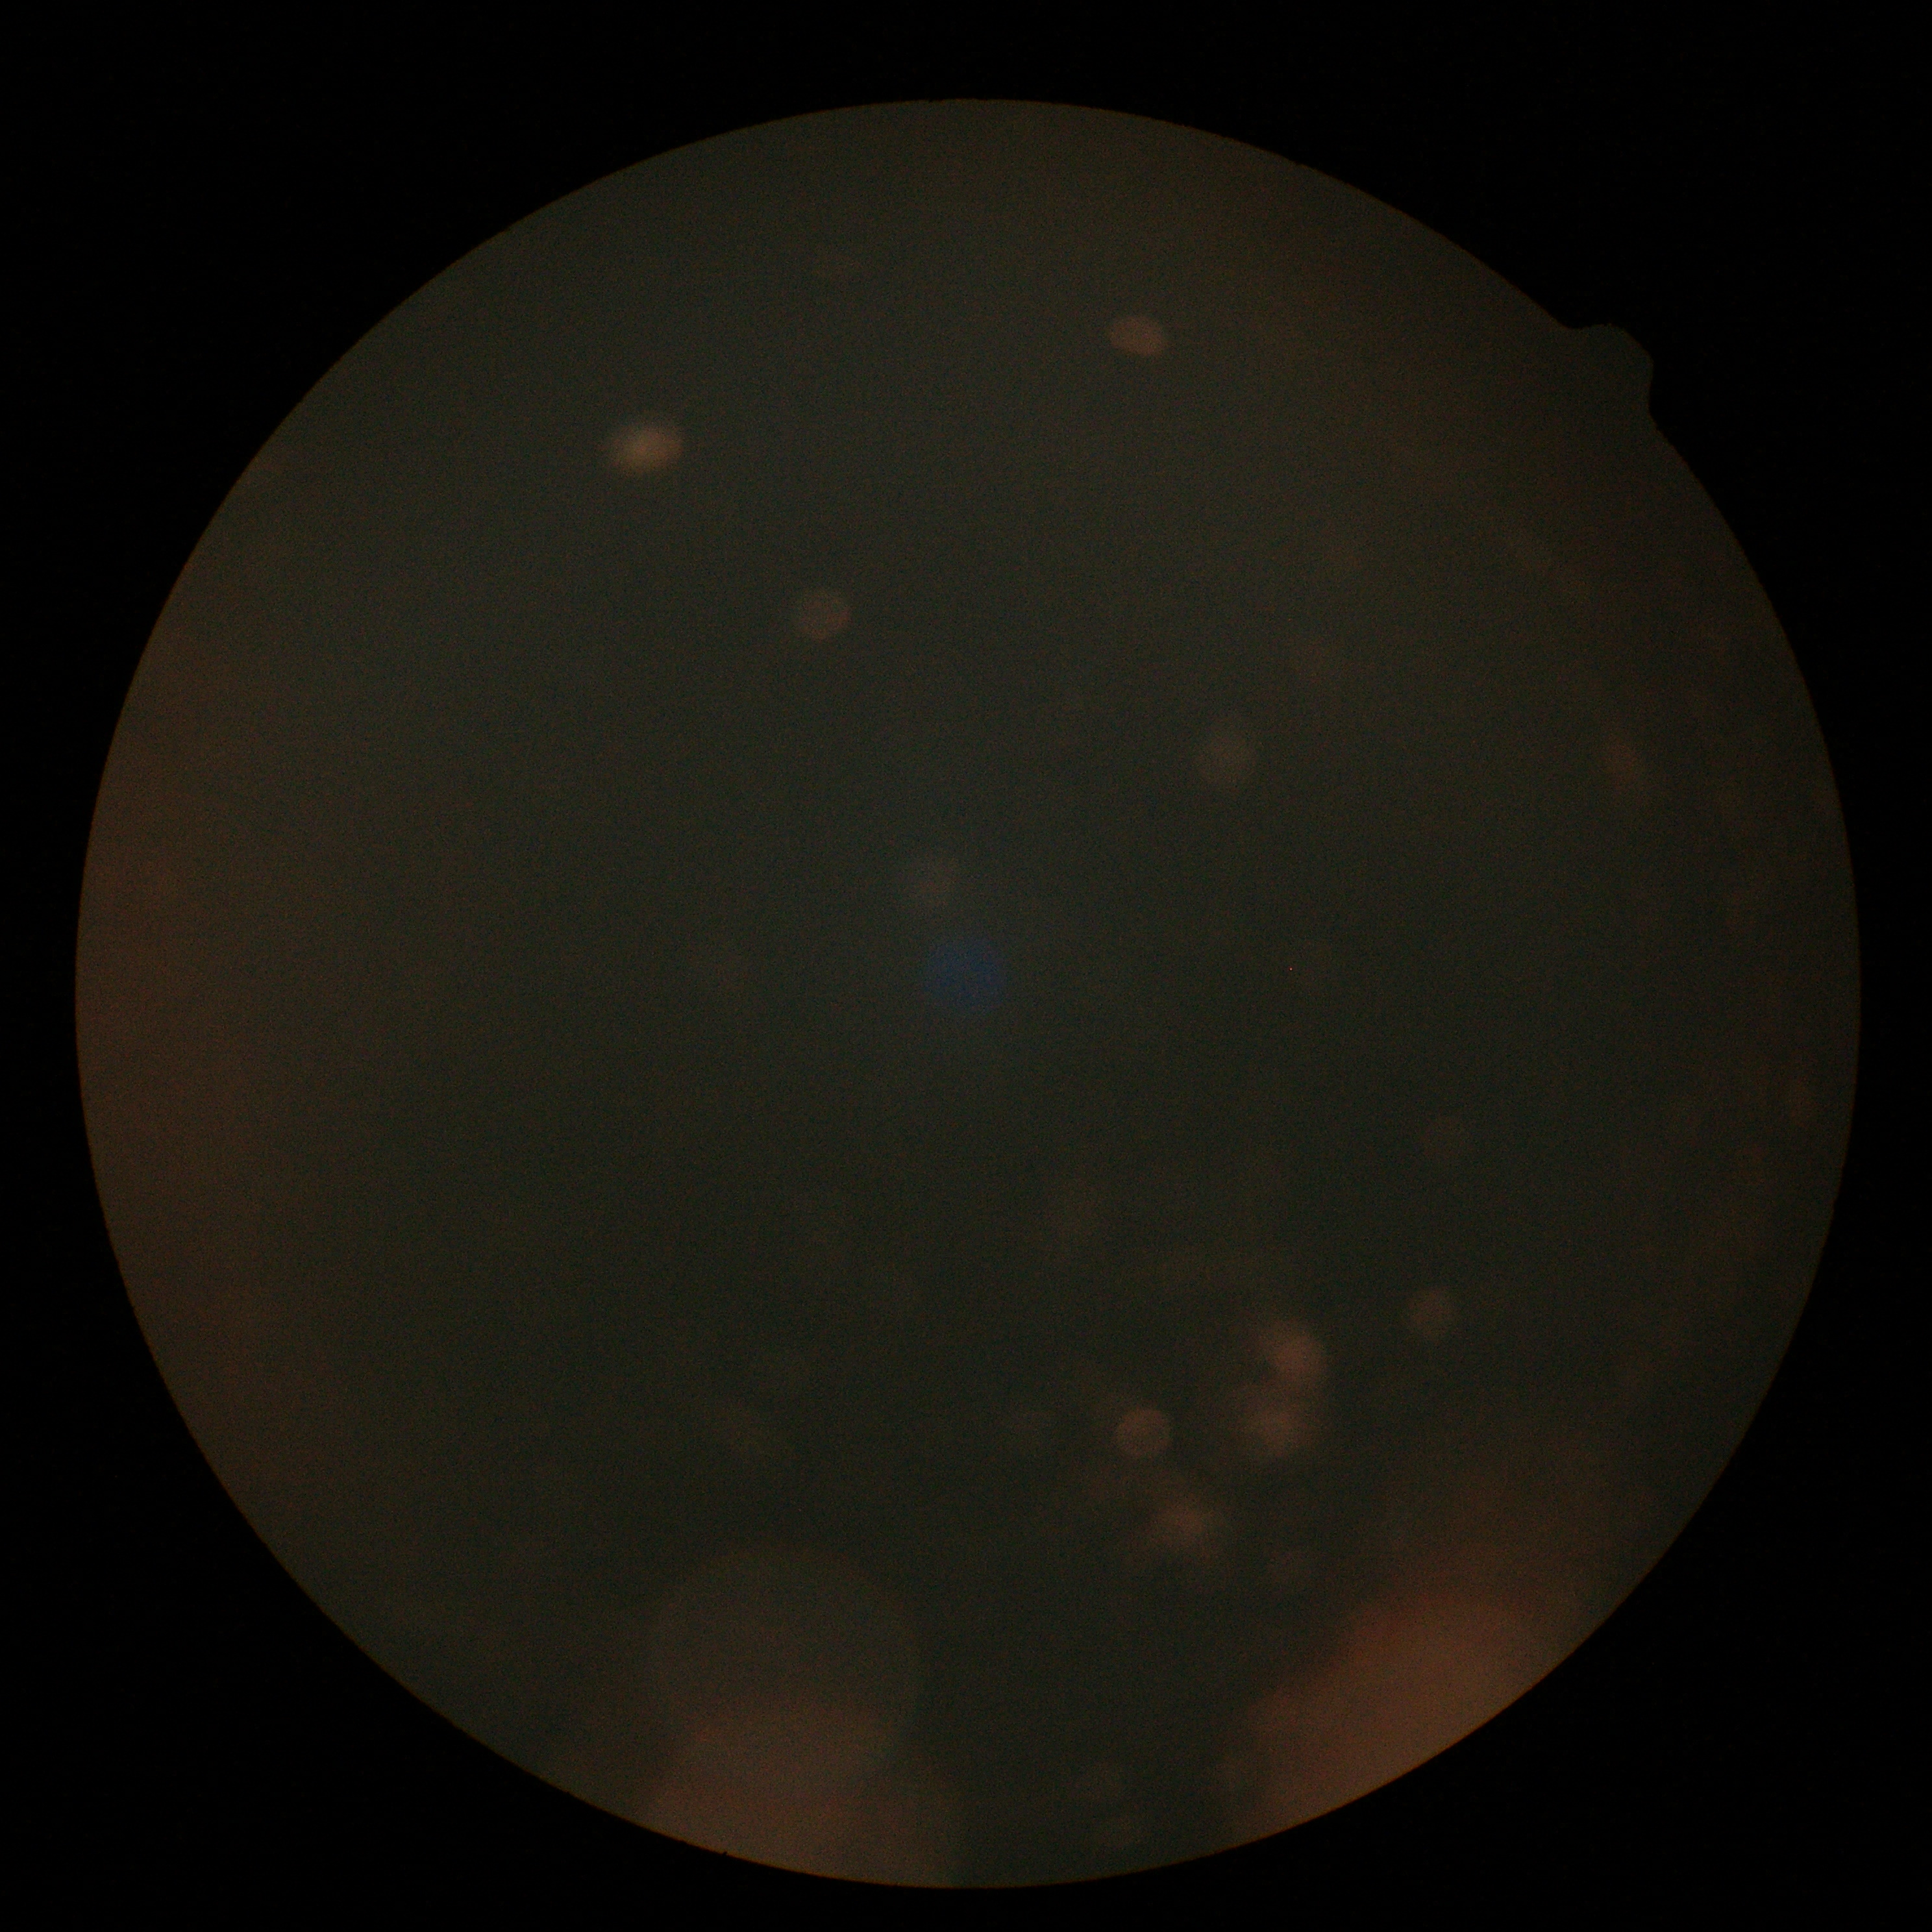

DR grade is ungradable due to poor image quality. Quality too poor to assess for DR.